2352 by 1568 pixels.
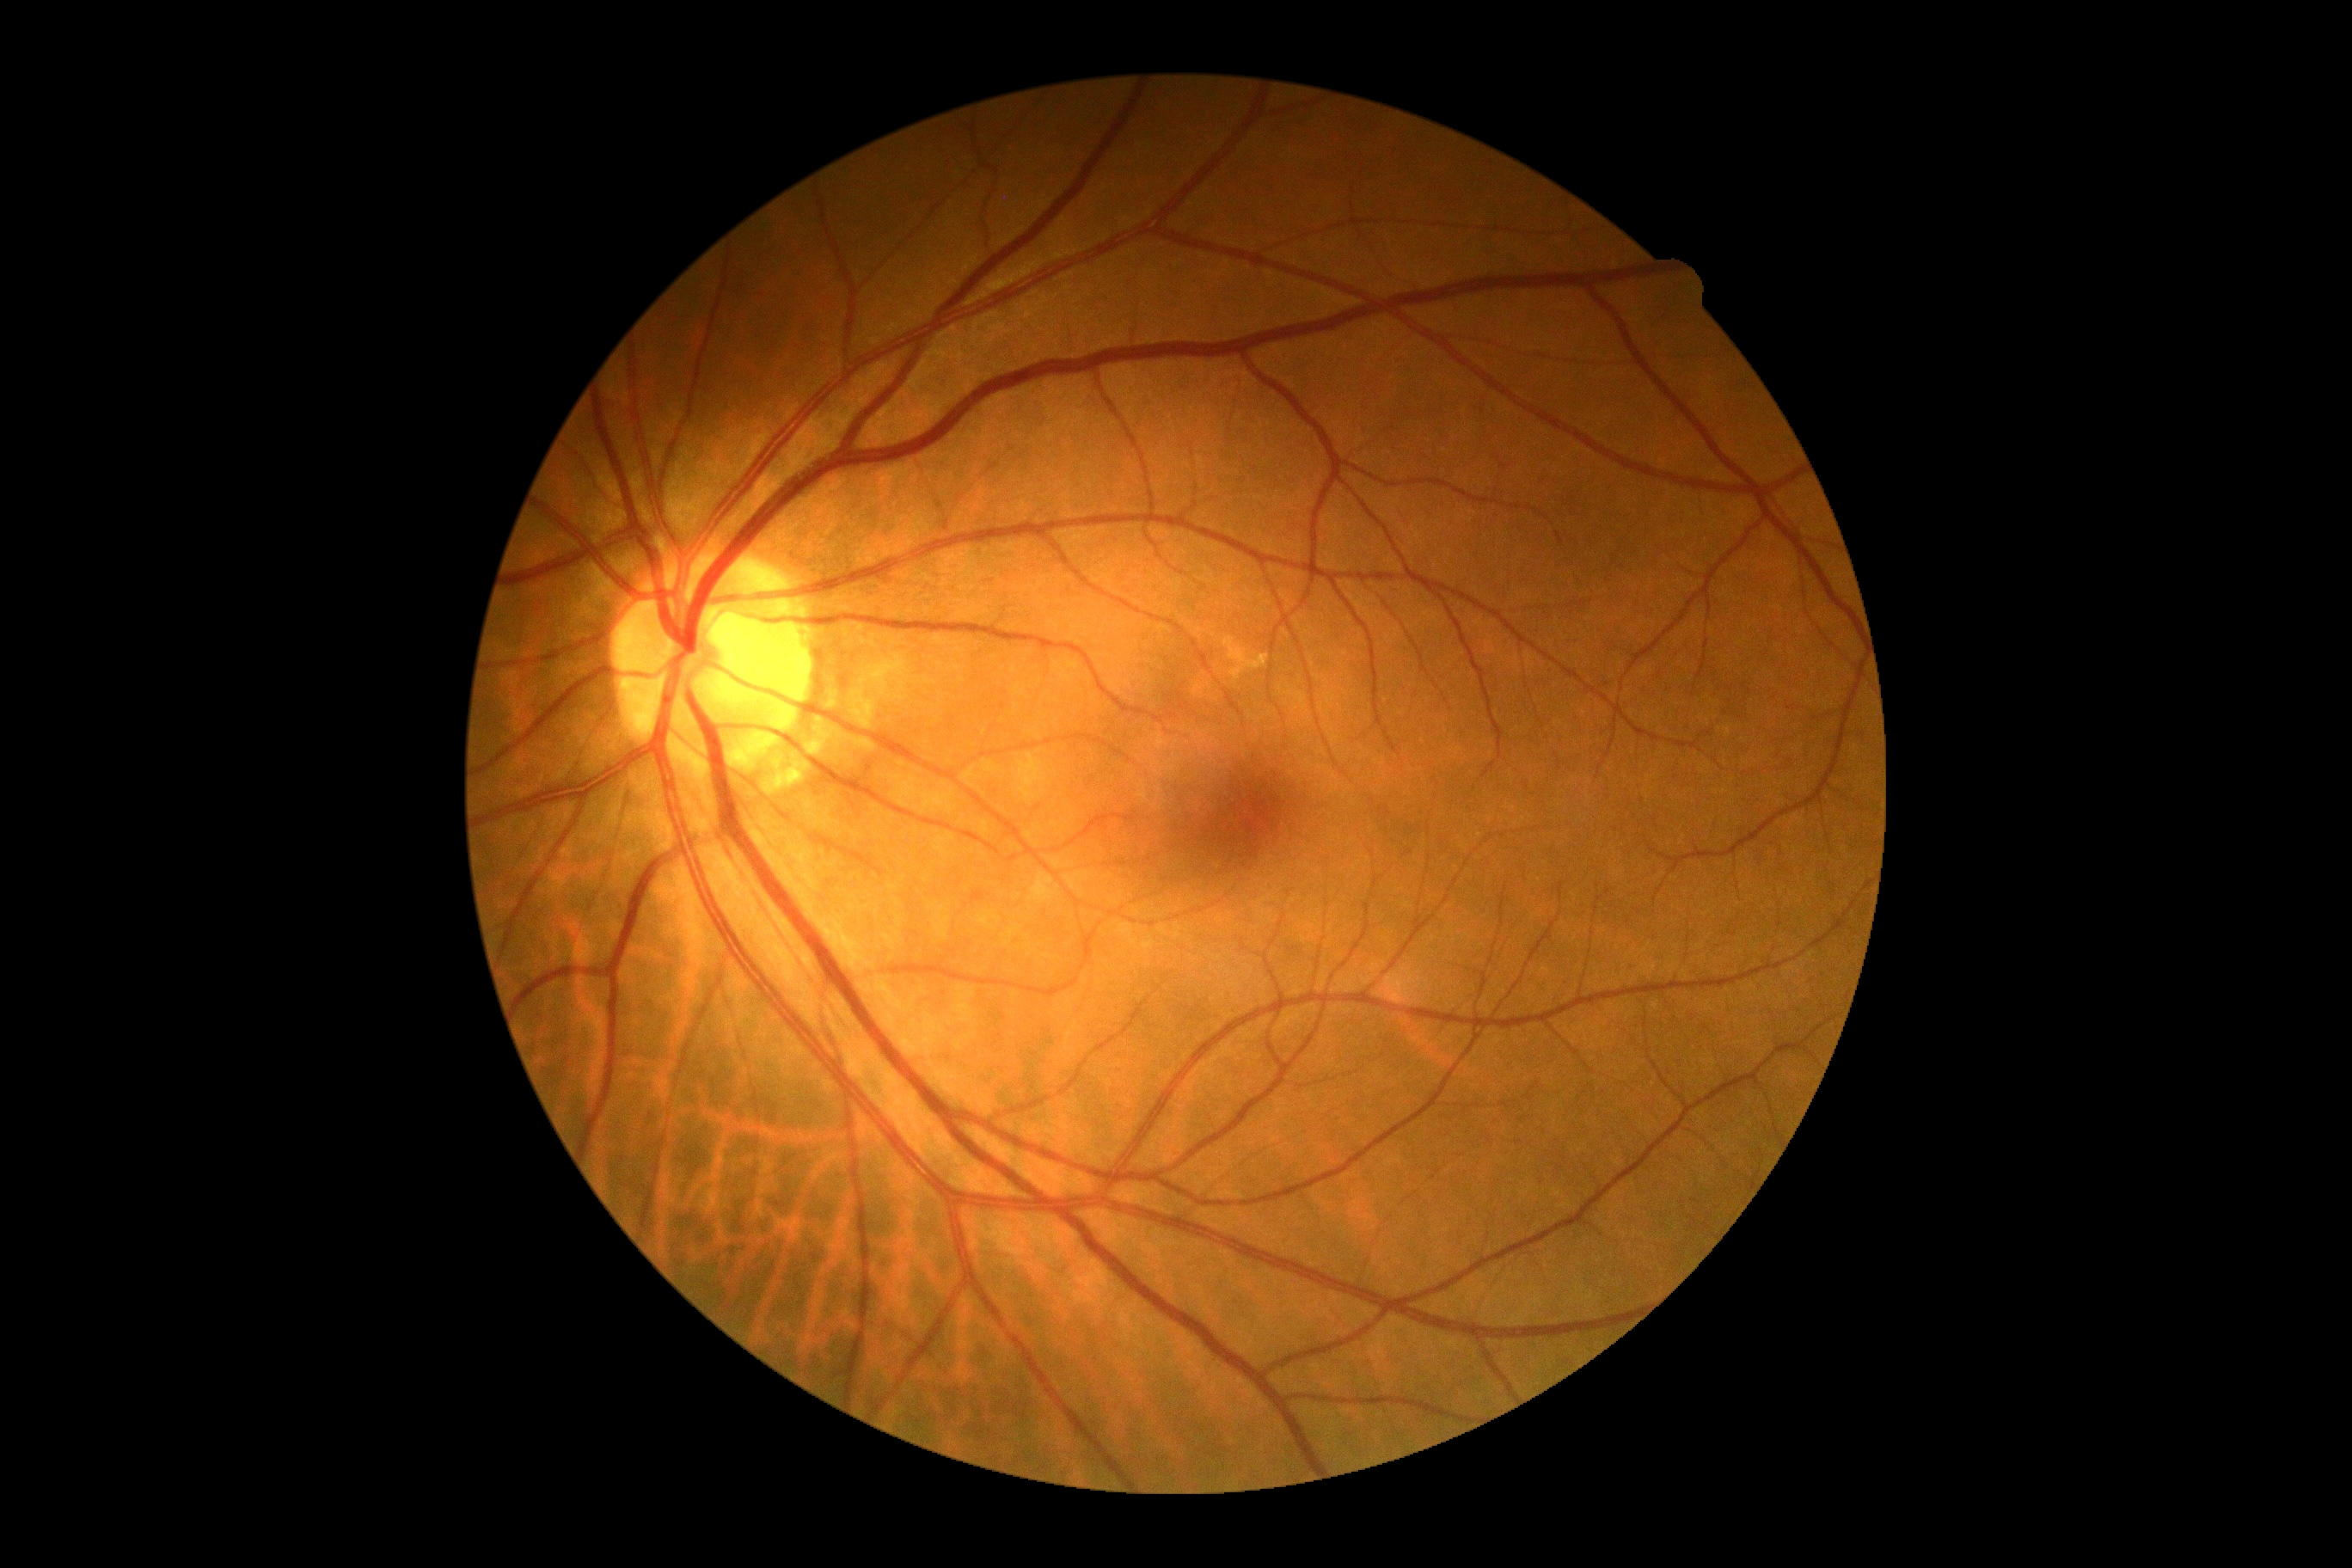
DR severity: no apparent retinopathy (grade 0).